45 degree fundus photograph. Posterior pole color fundus photograph. Acquired with a NIDEK AFC-230.
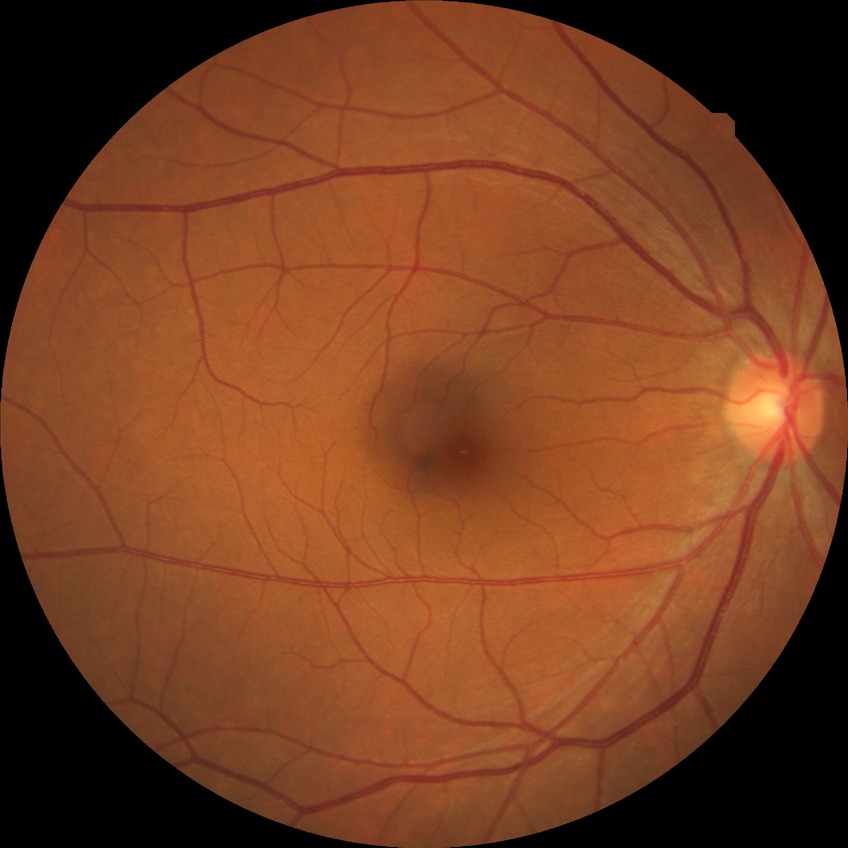

Modified Davis grading: no diabetic retinopathy.